Infant wide-field fundus photograph; 1240x1240px
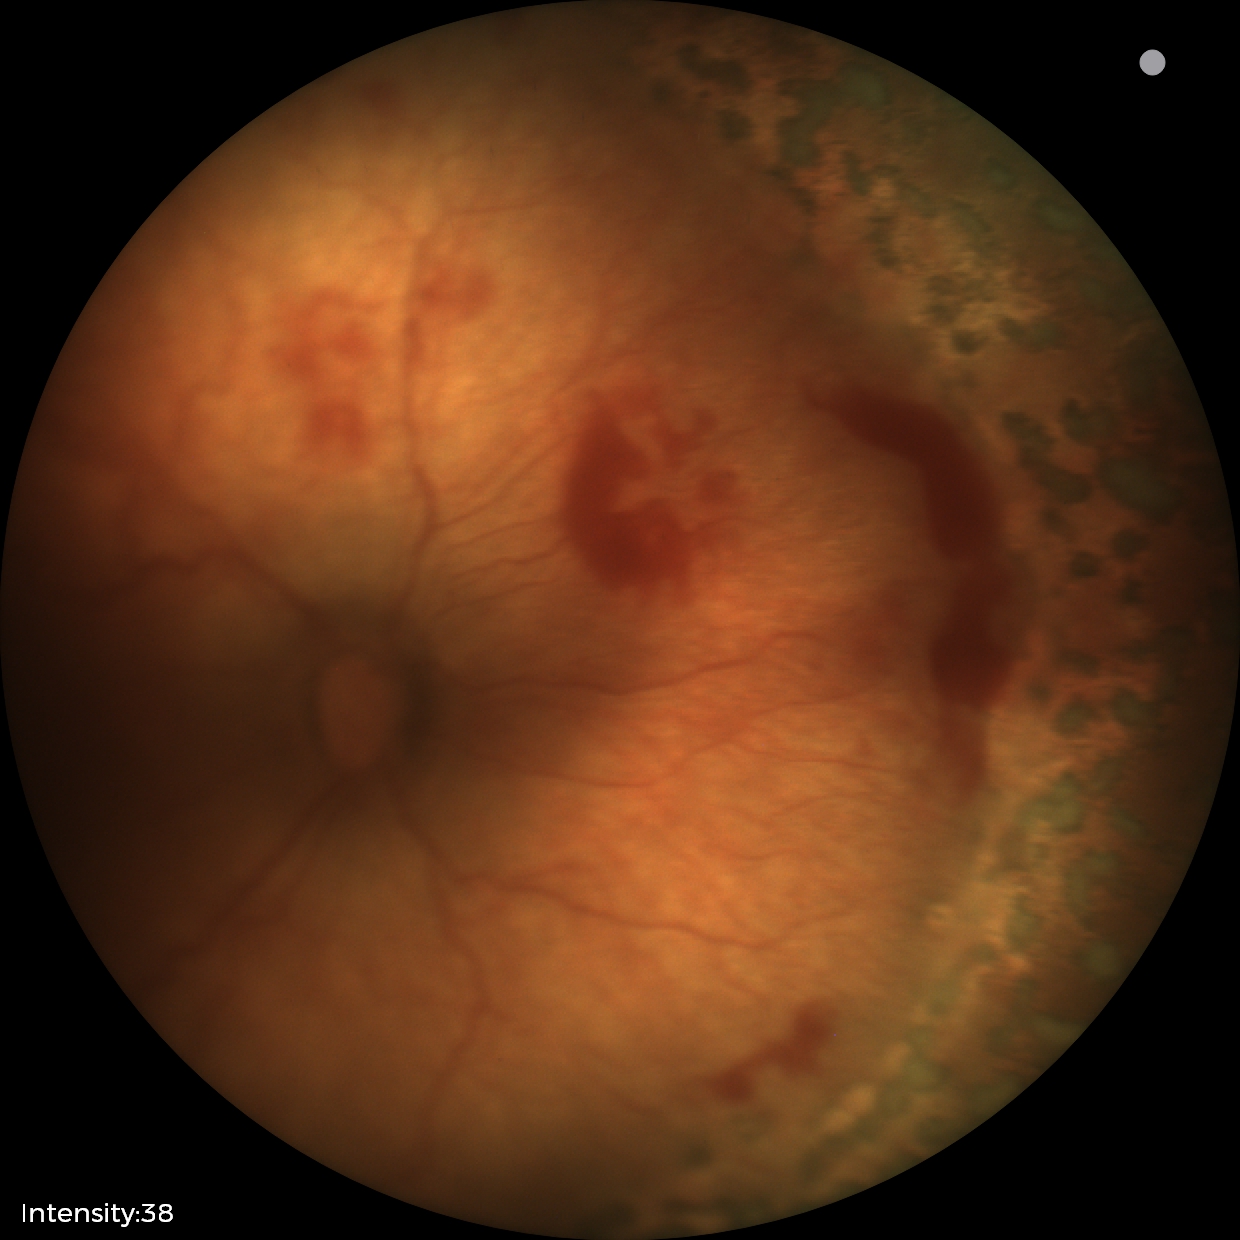 Series diagnosed as status post retinopathy of prematurity.